Color fundus photograph:
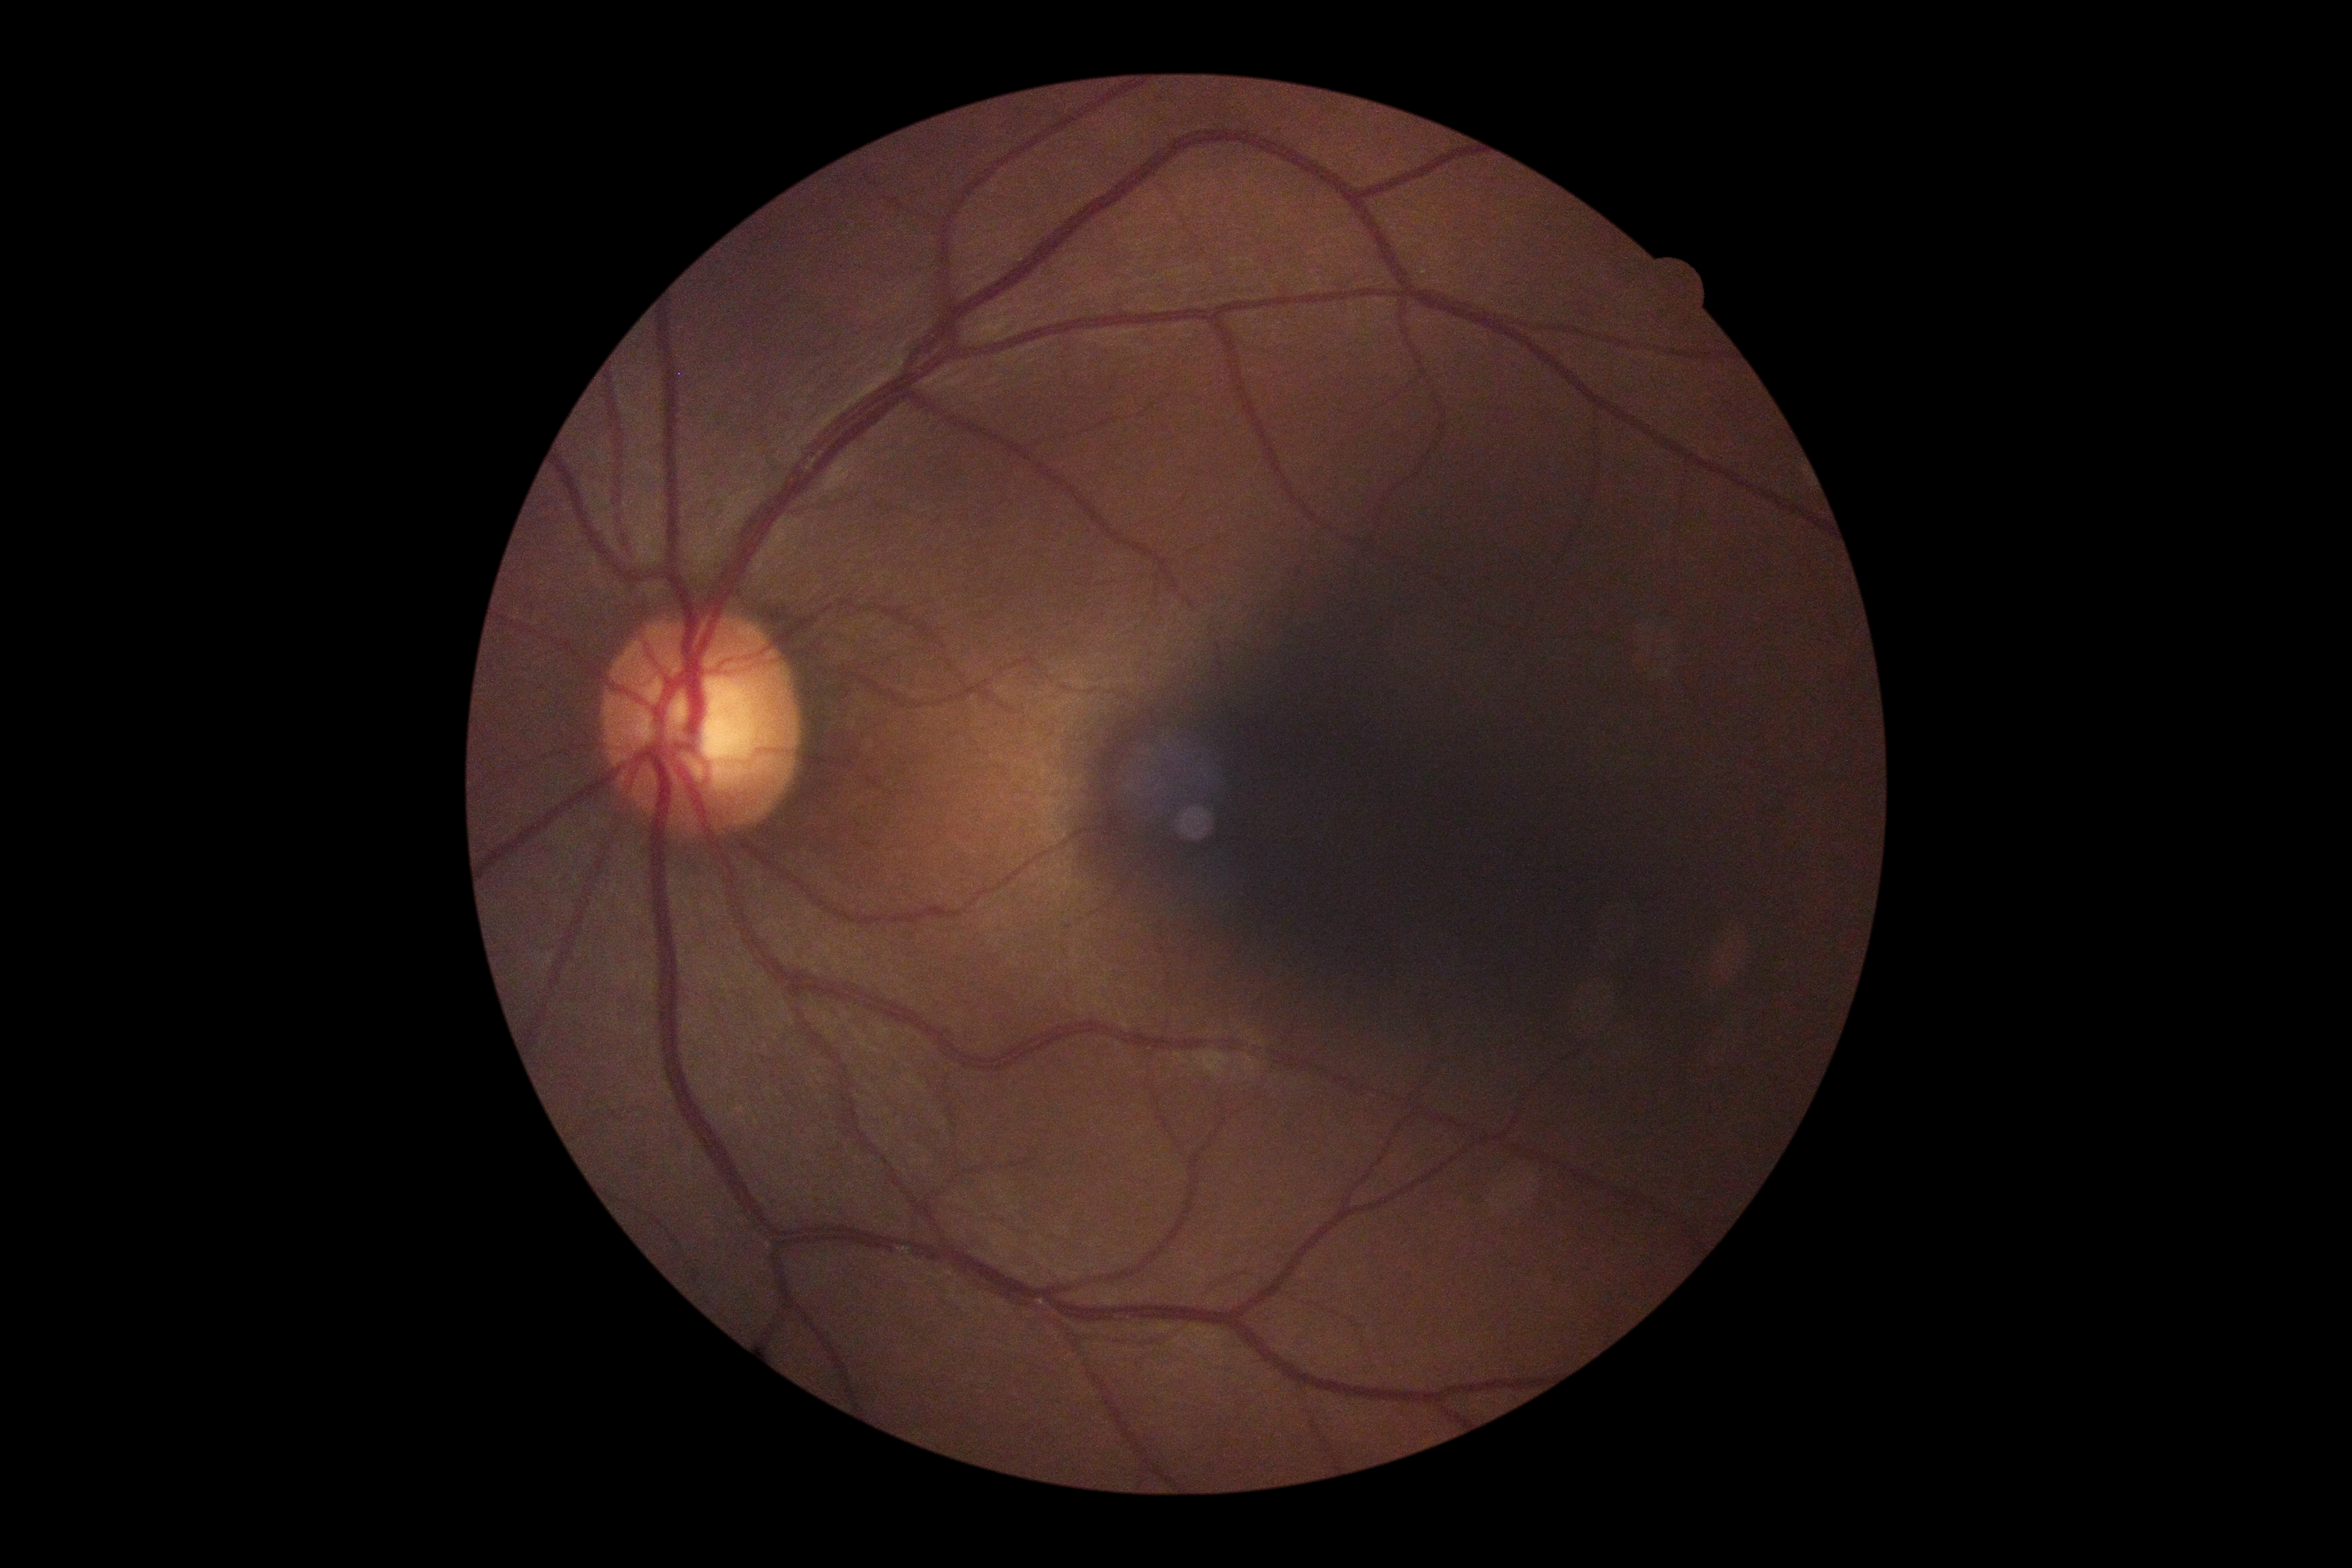
diabetic retinopathy: grade 0 (no apparent retinopathy)